Captured on a Nidek AFC-330 fundus camera — 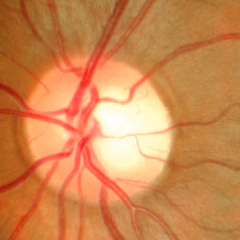

No evidence of glaucoma.